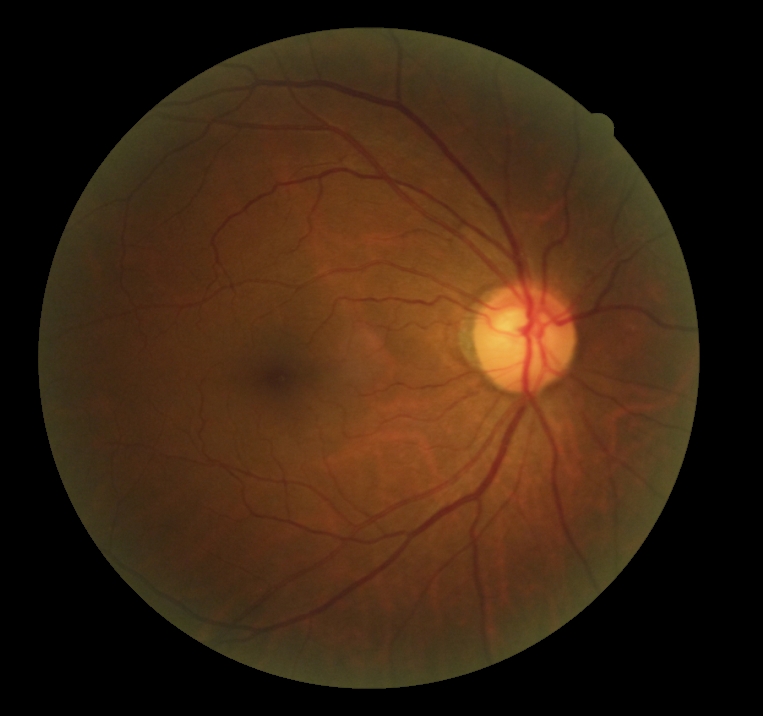 DR severity@0/4.